CFP, 2048 by 1536 pixels, 45° FOV — 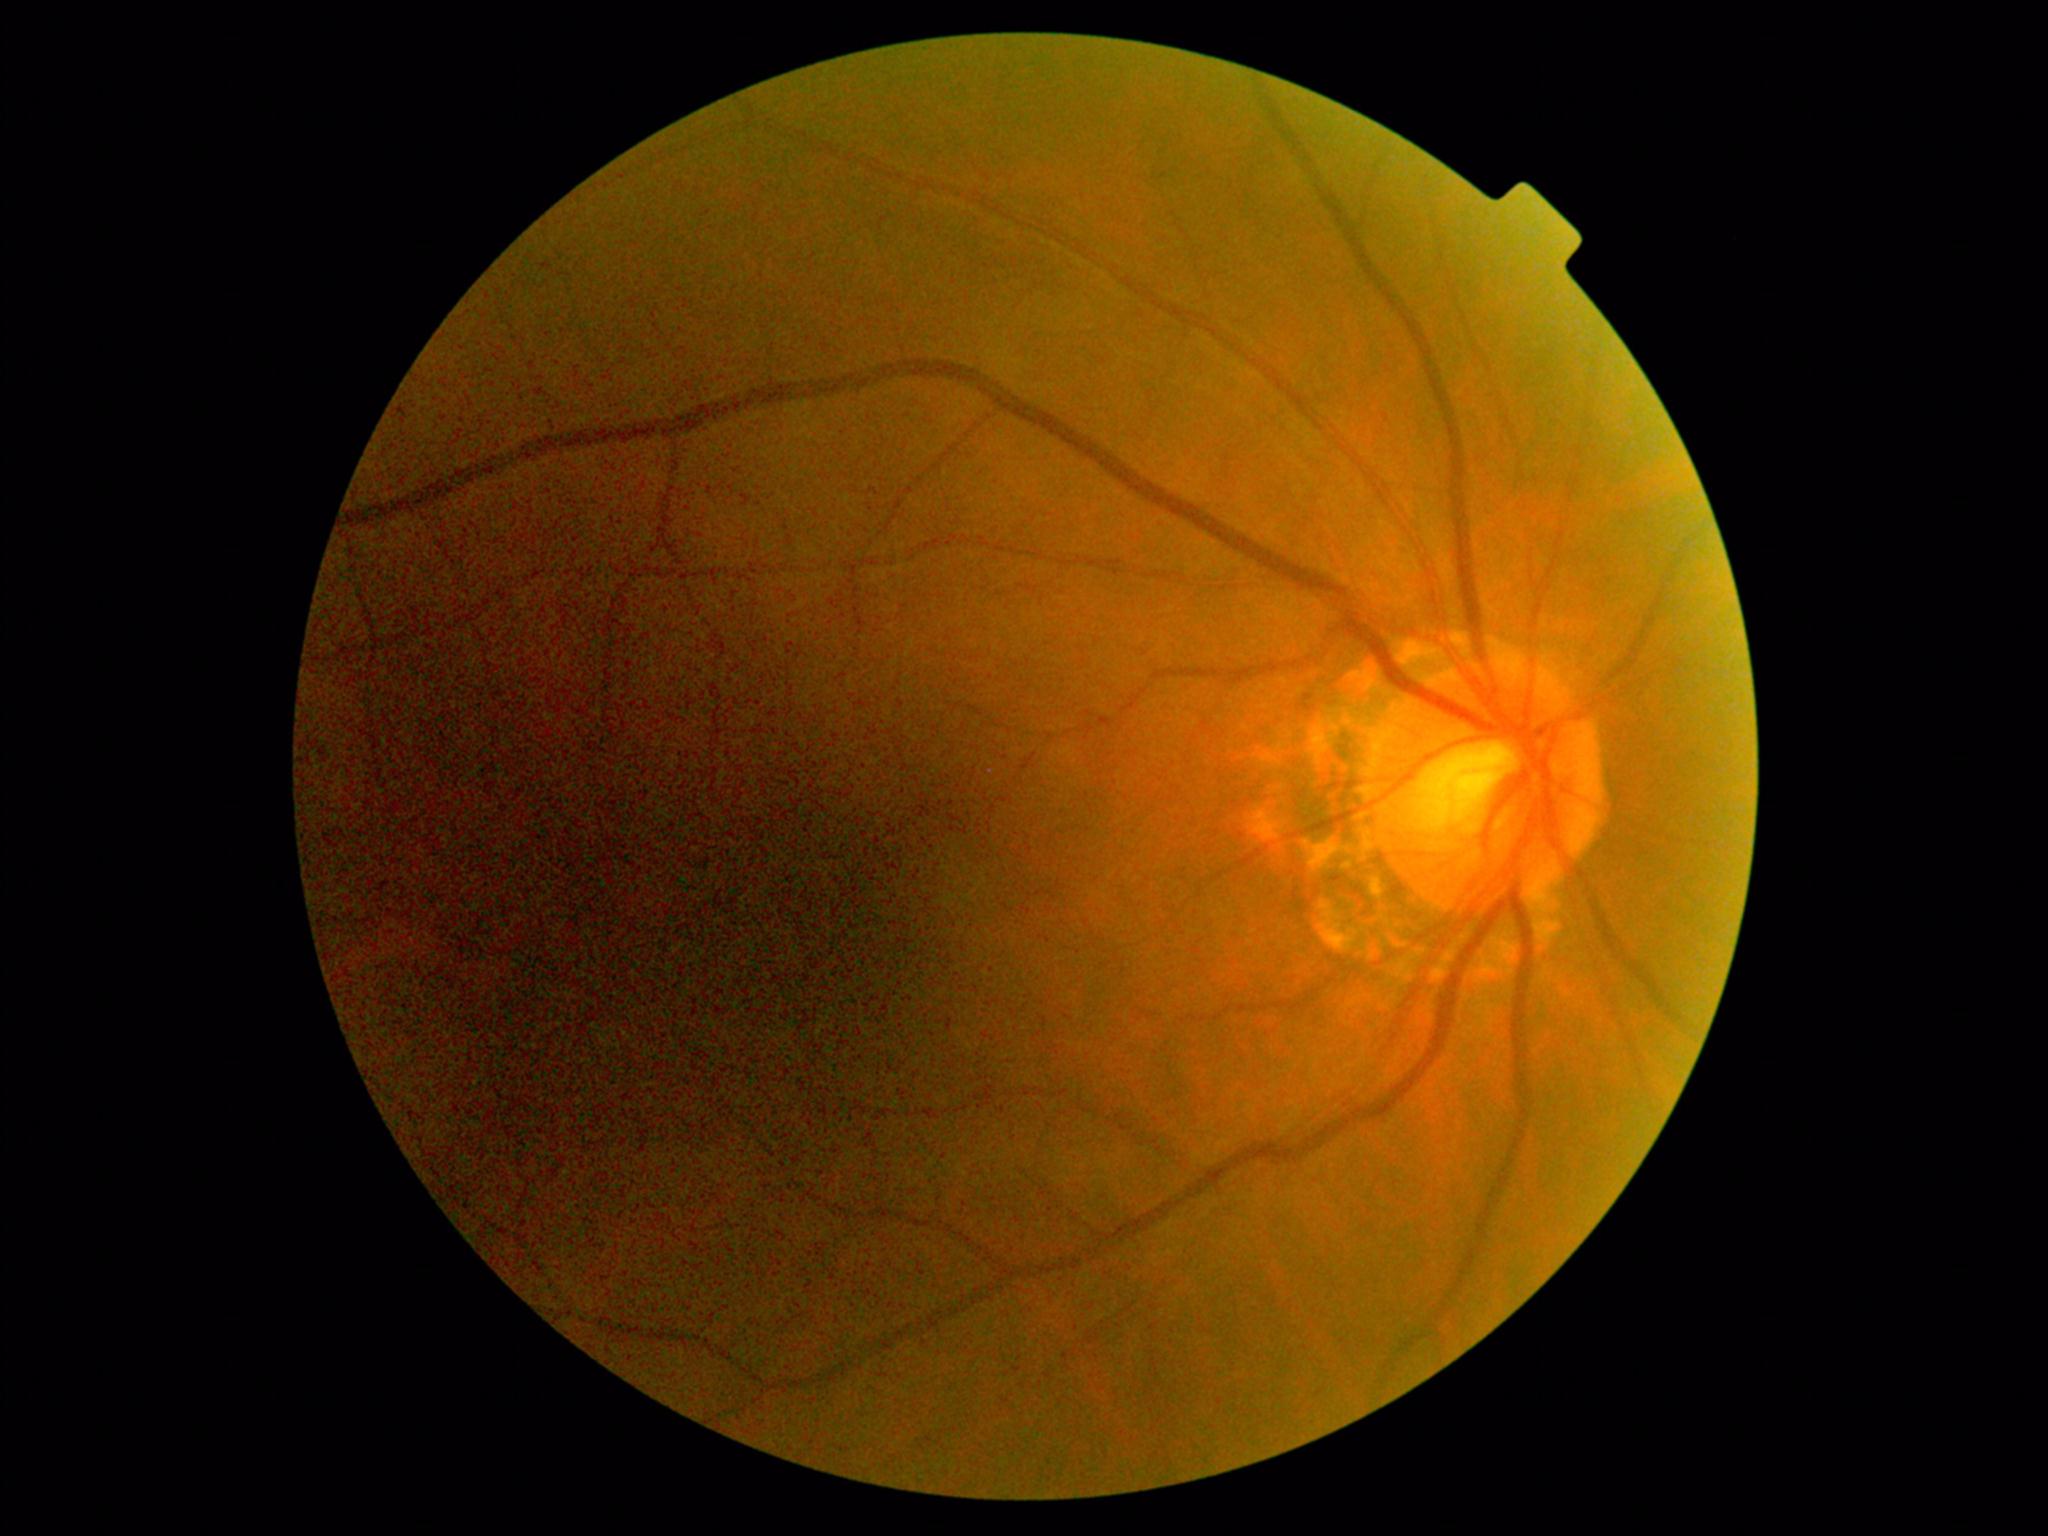 Diabetic retinopathy (DR): grade 0 — no visible signs of diabetic retinopathy.